Infant wide-field fundus photograph — 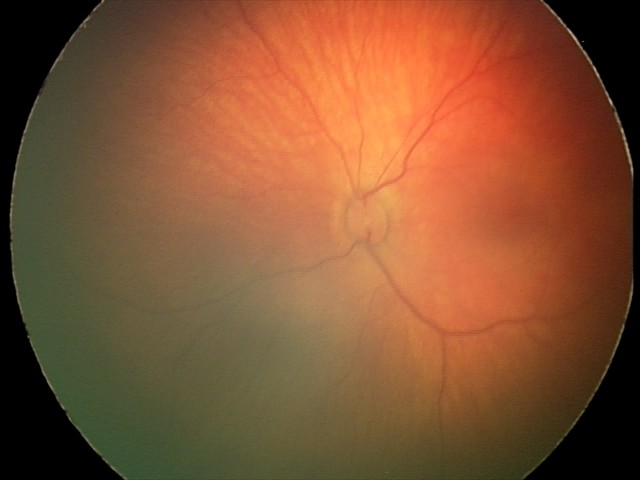

Q: What was the screening finding?
A: retinal hemorrhages